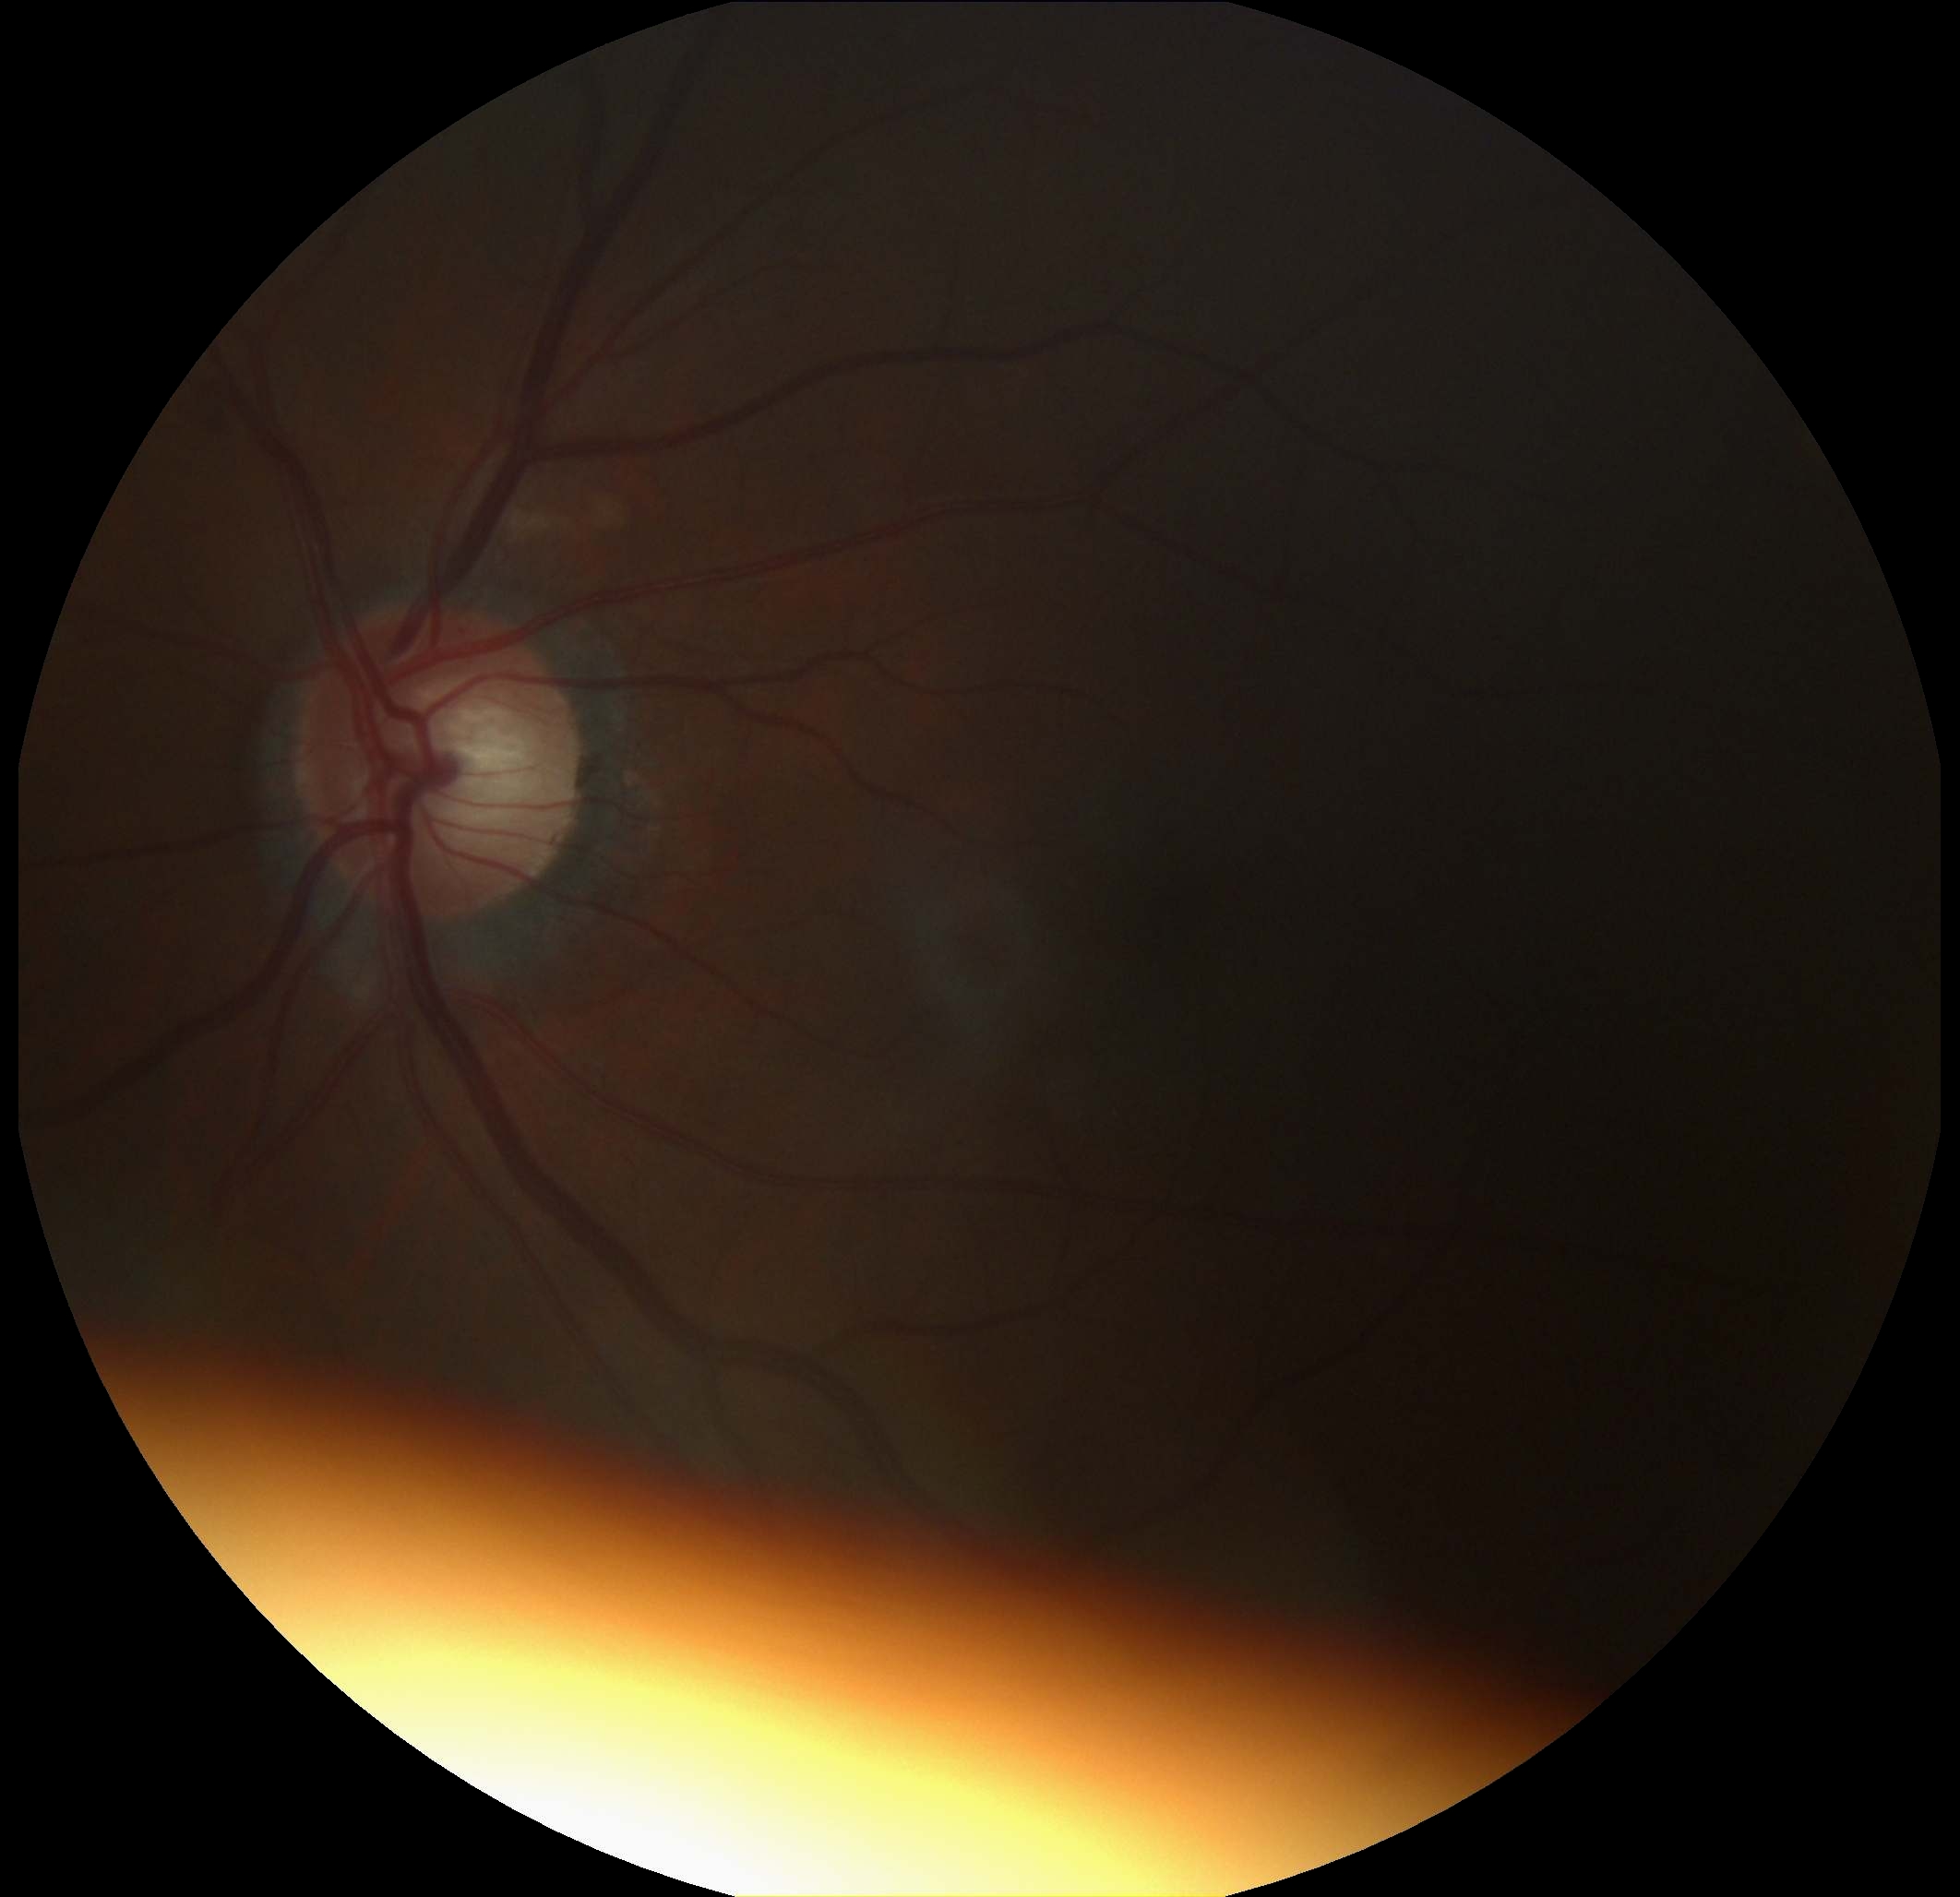
DR grade is 2.